Acquired on the Natus RetCam Envision · infant wide-field retinal image:
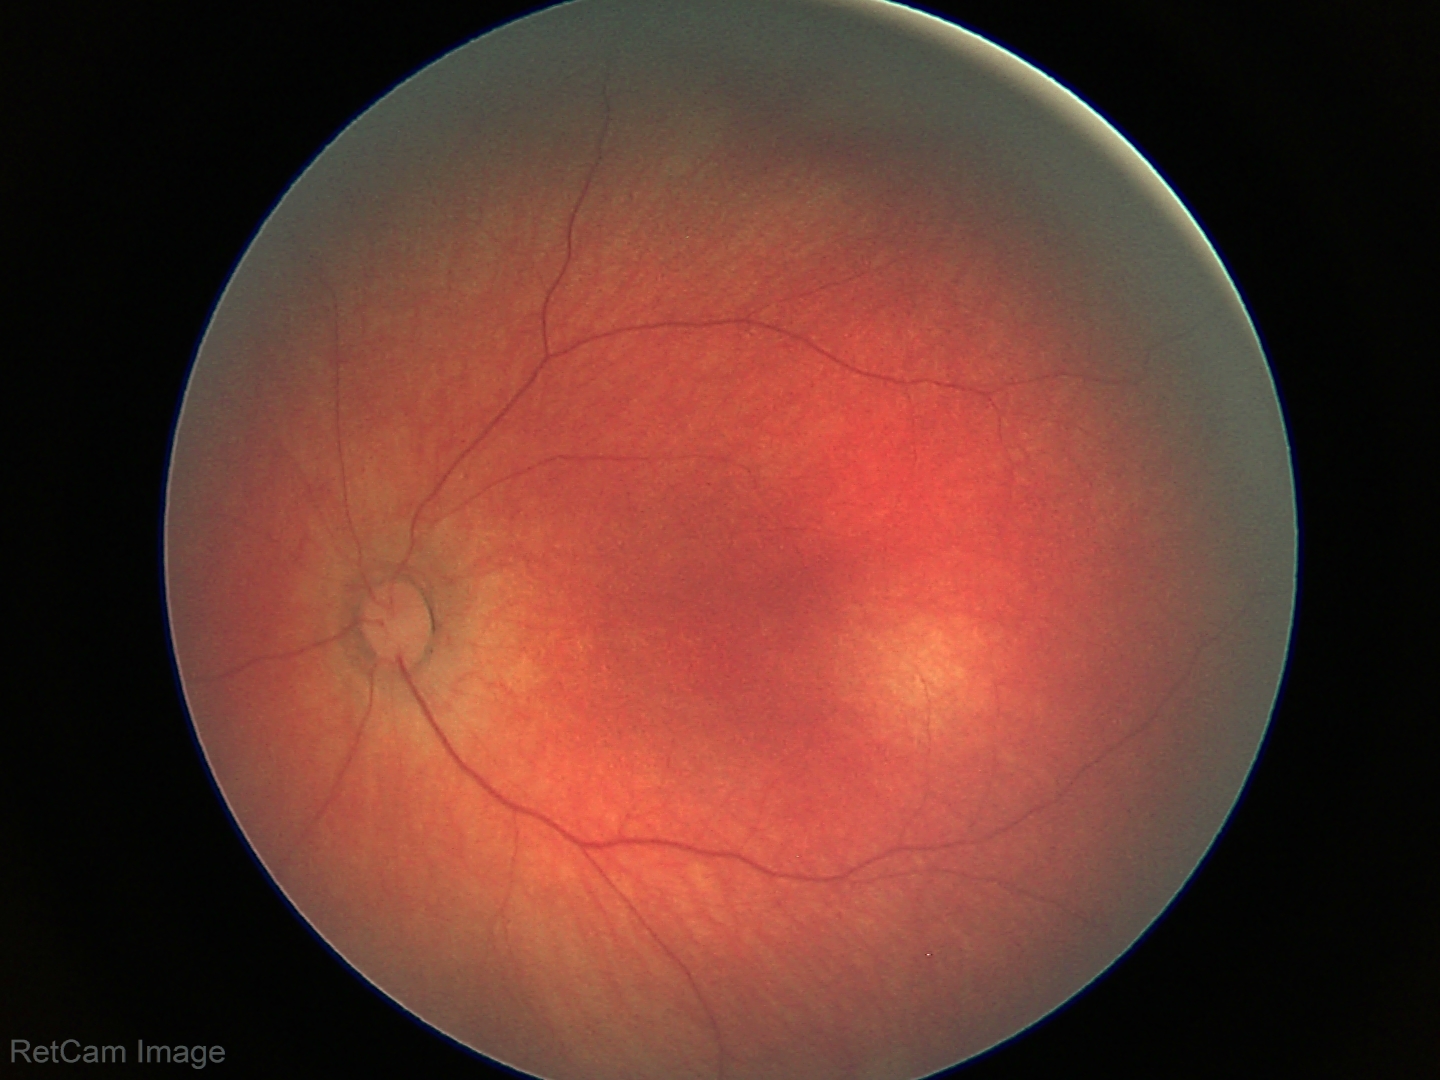

Impression: physiological finding.